Wide-field fundus image from infant ROP screening.
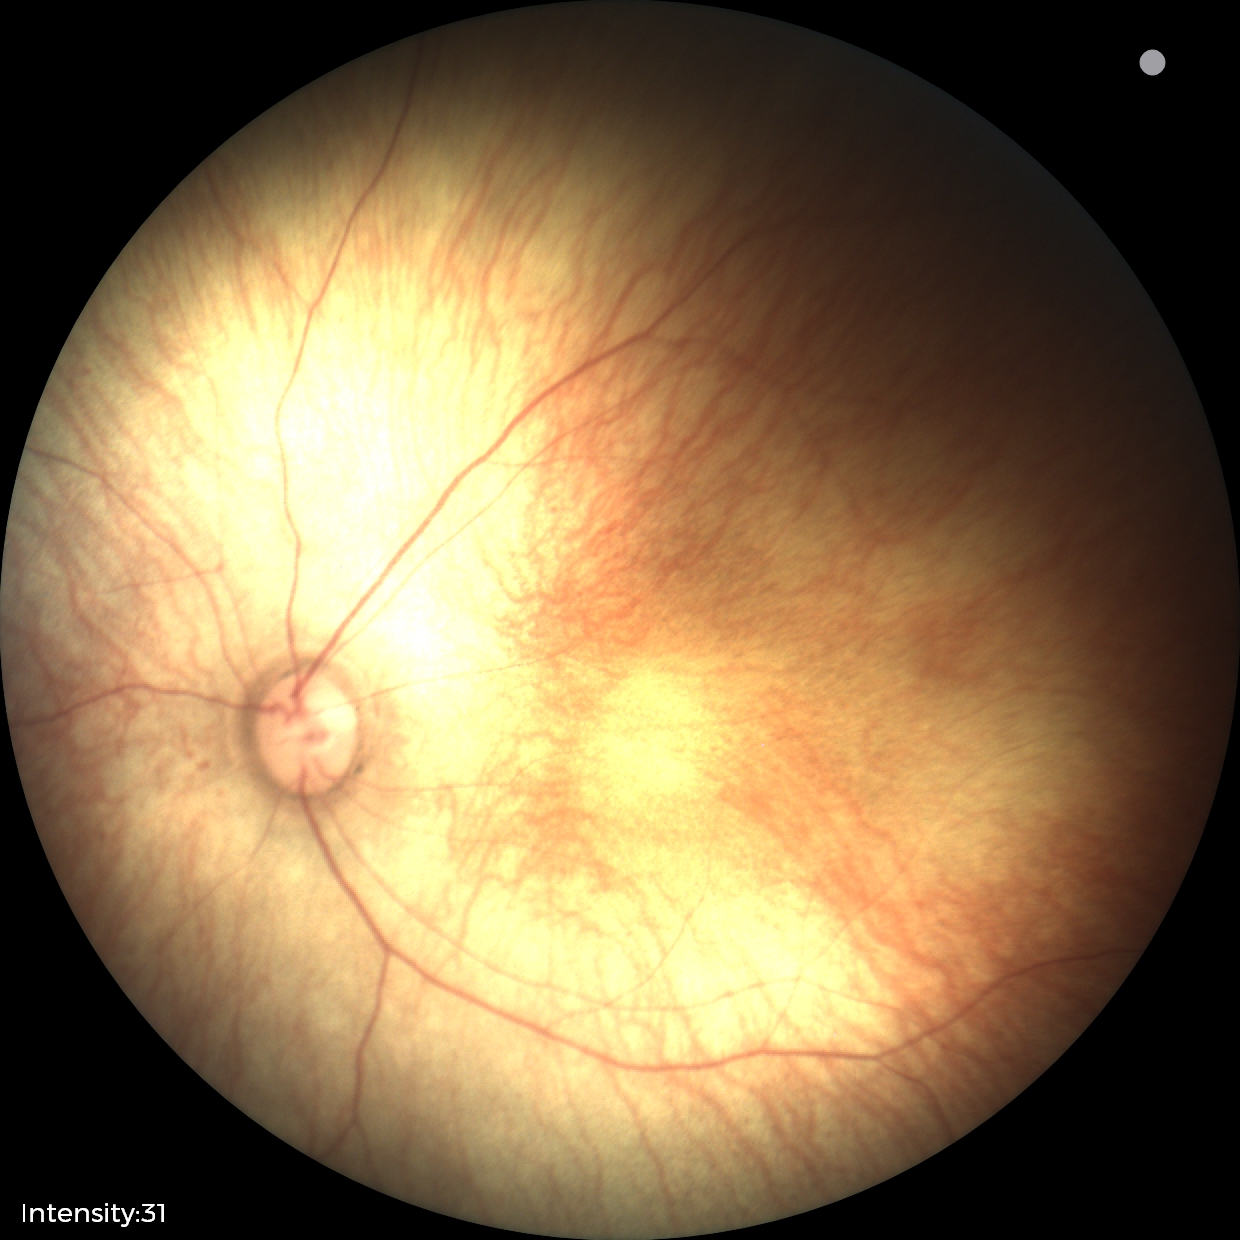

Physiological retinal appearance for postconceptual age.